Pediatric wide-field fundus photograph — 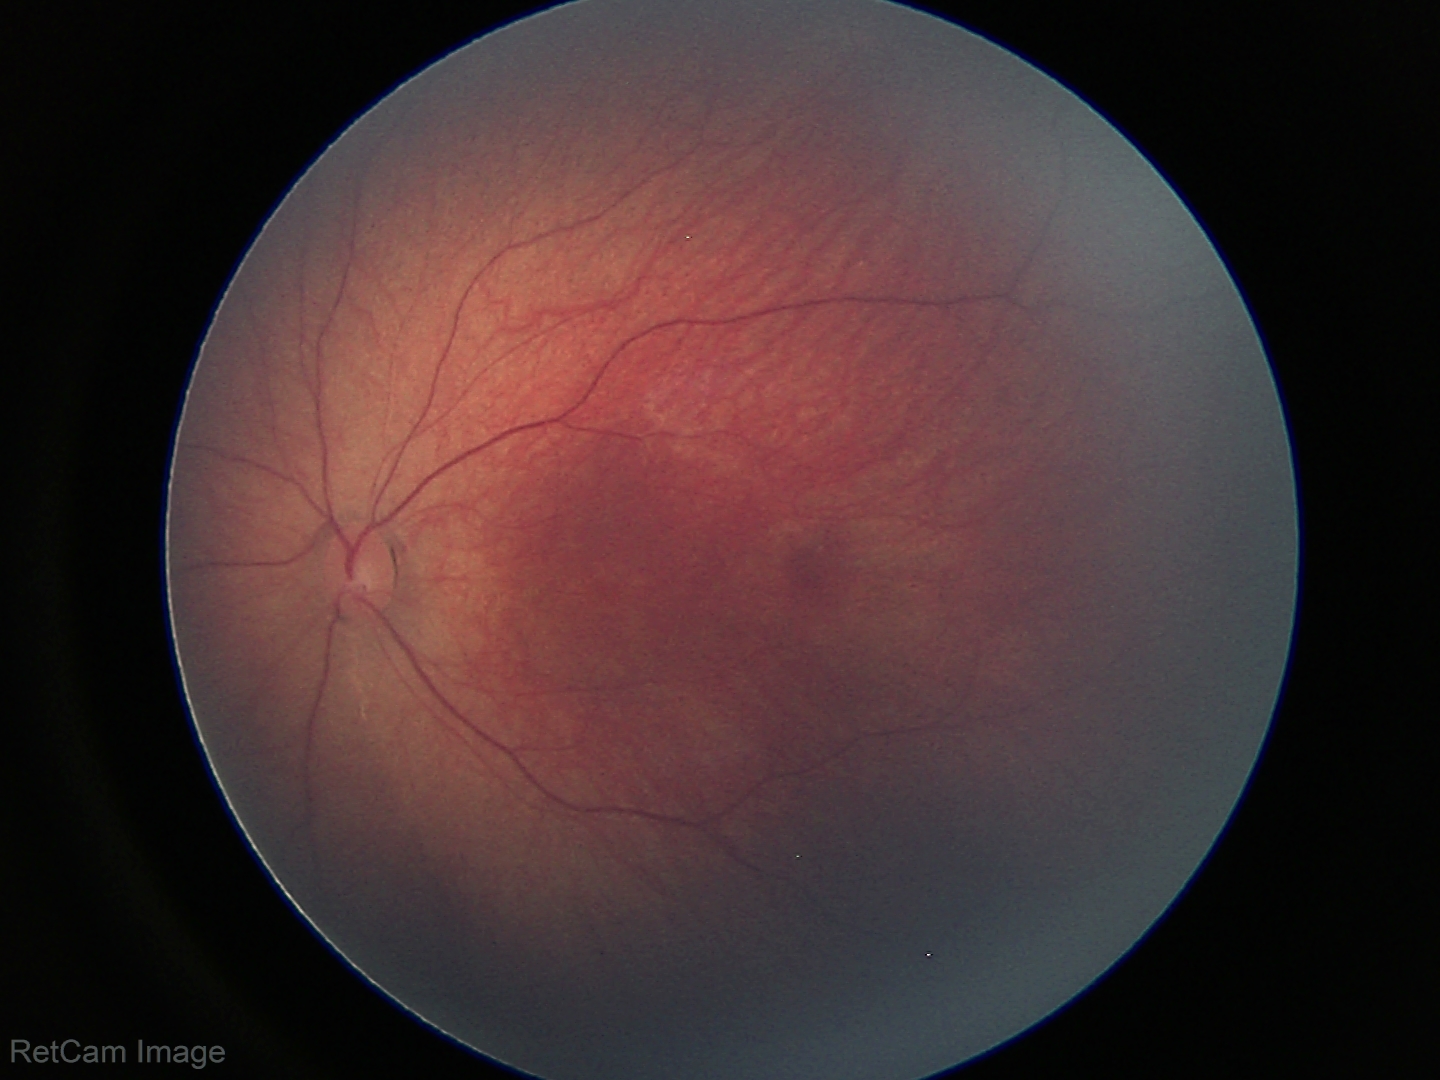
Screening examination with no abnormal retinal findings.